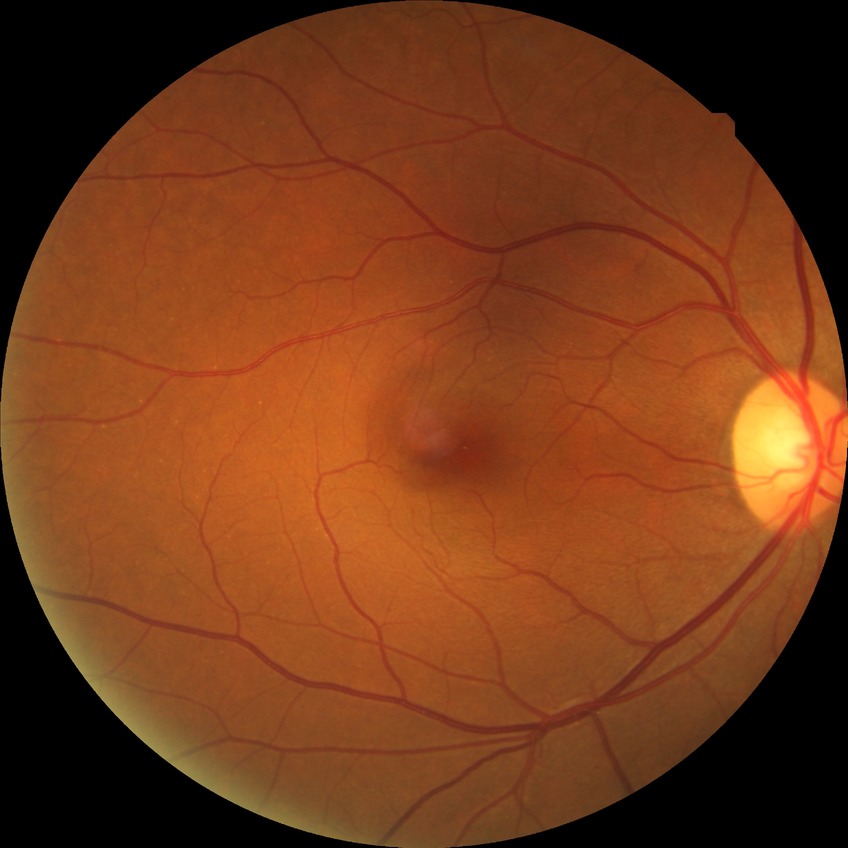 Diabetic retinopathy (DR) is no diabetic retinopathy (NDR).